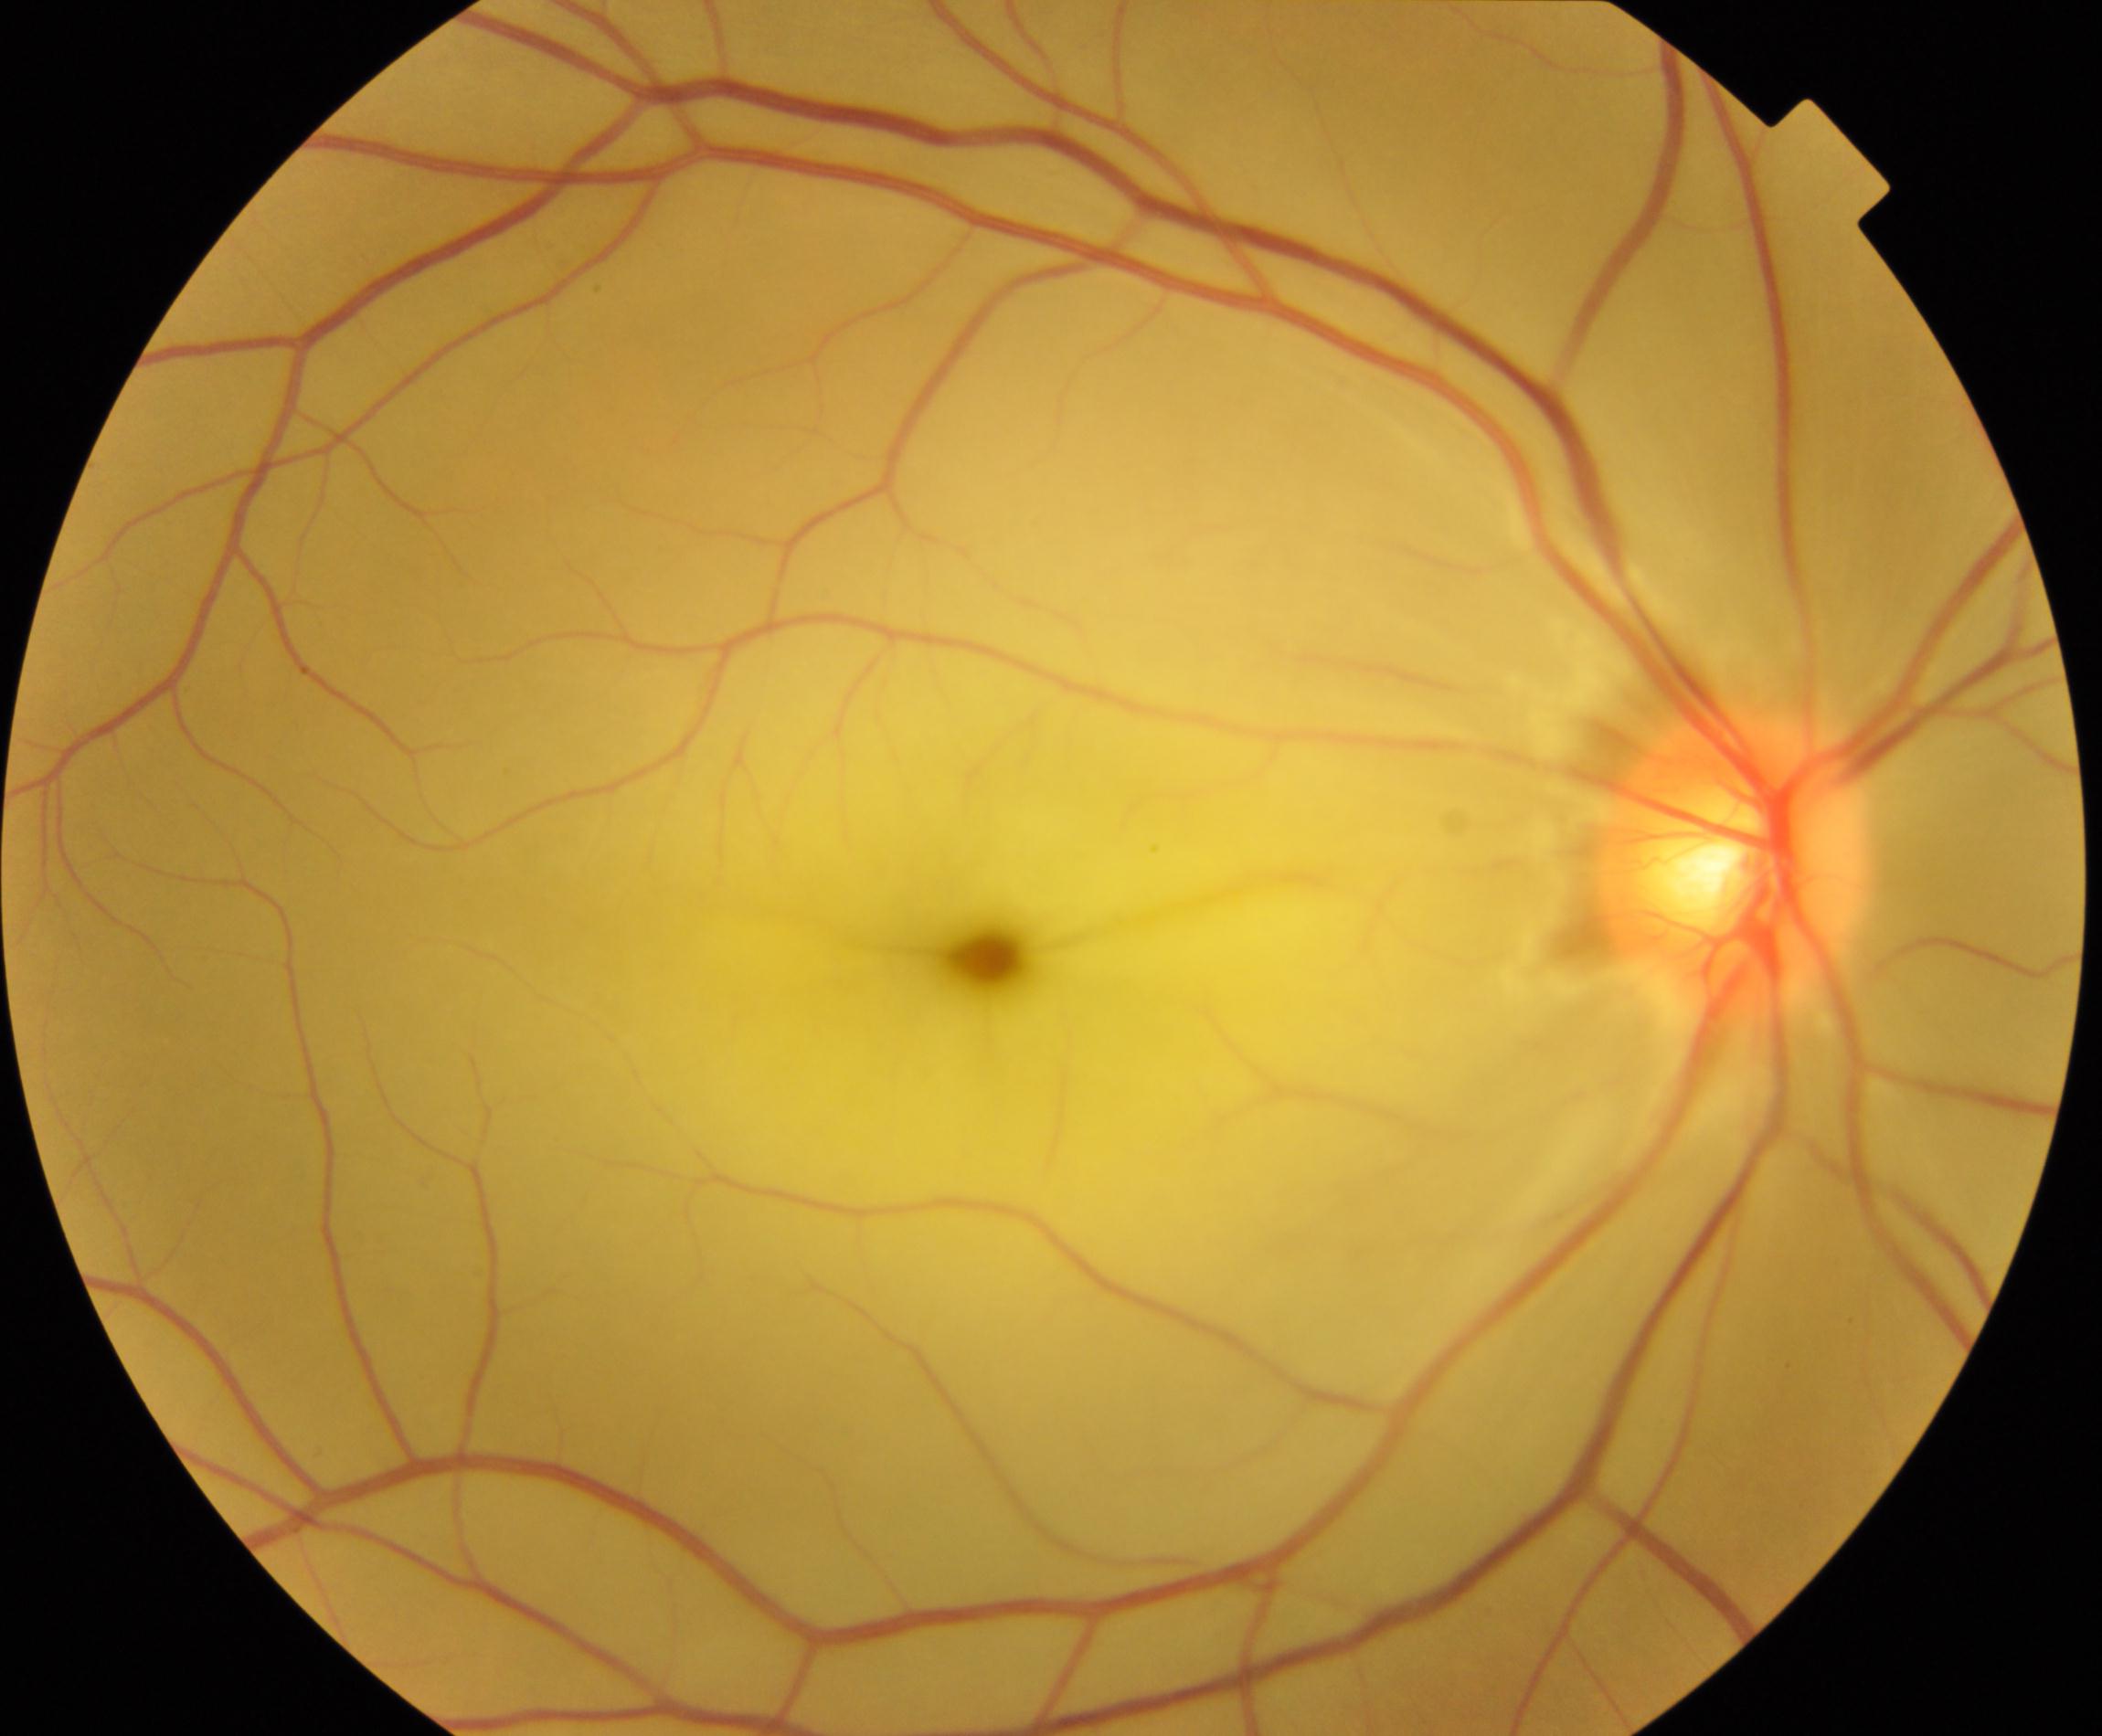
Diagnosis: retinal artery occlusion (RAO). Characterized by attenuation of arteries and veins with a cherry-red fovea, in contrast to the cloudy white edematous retina affected by the artery occlusion.